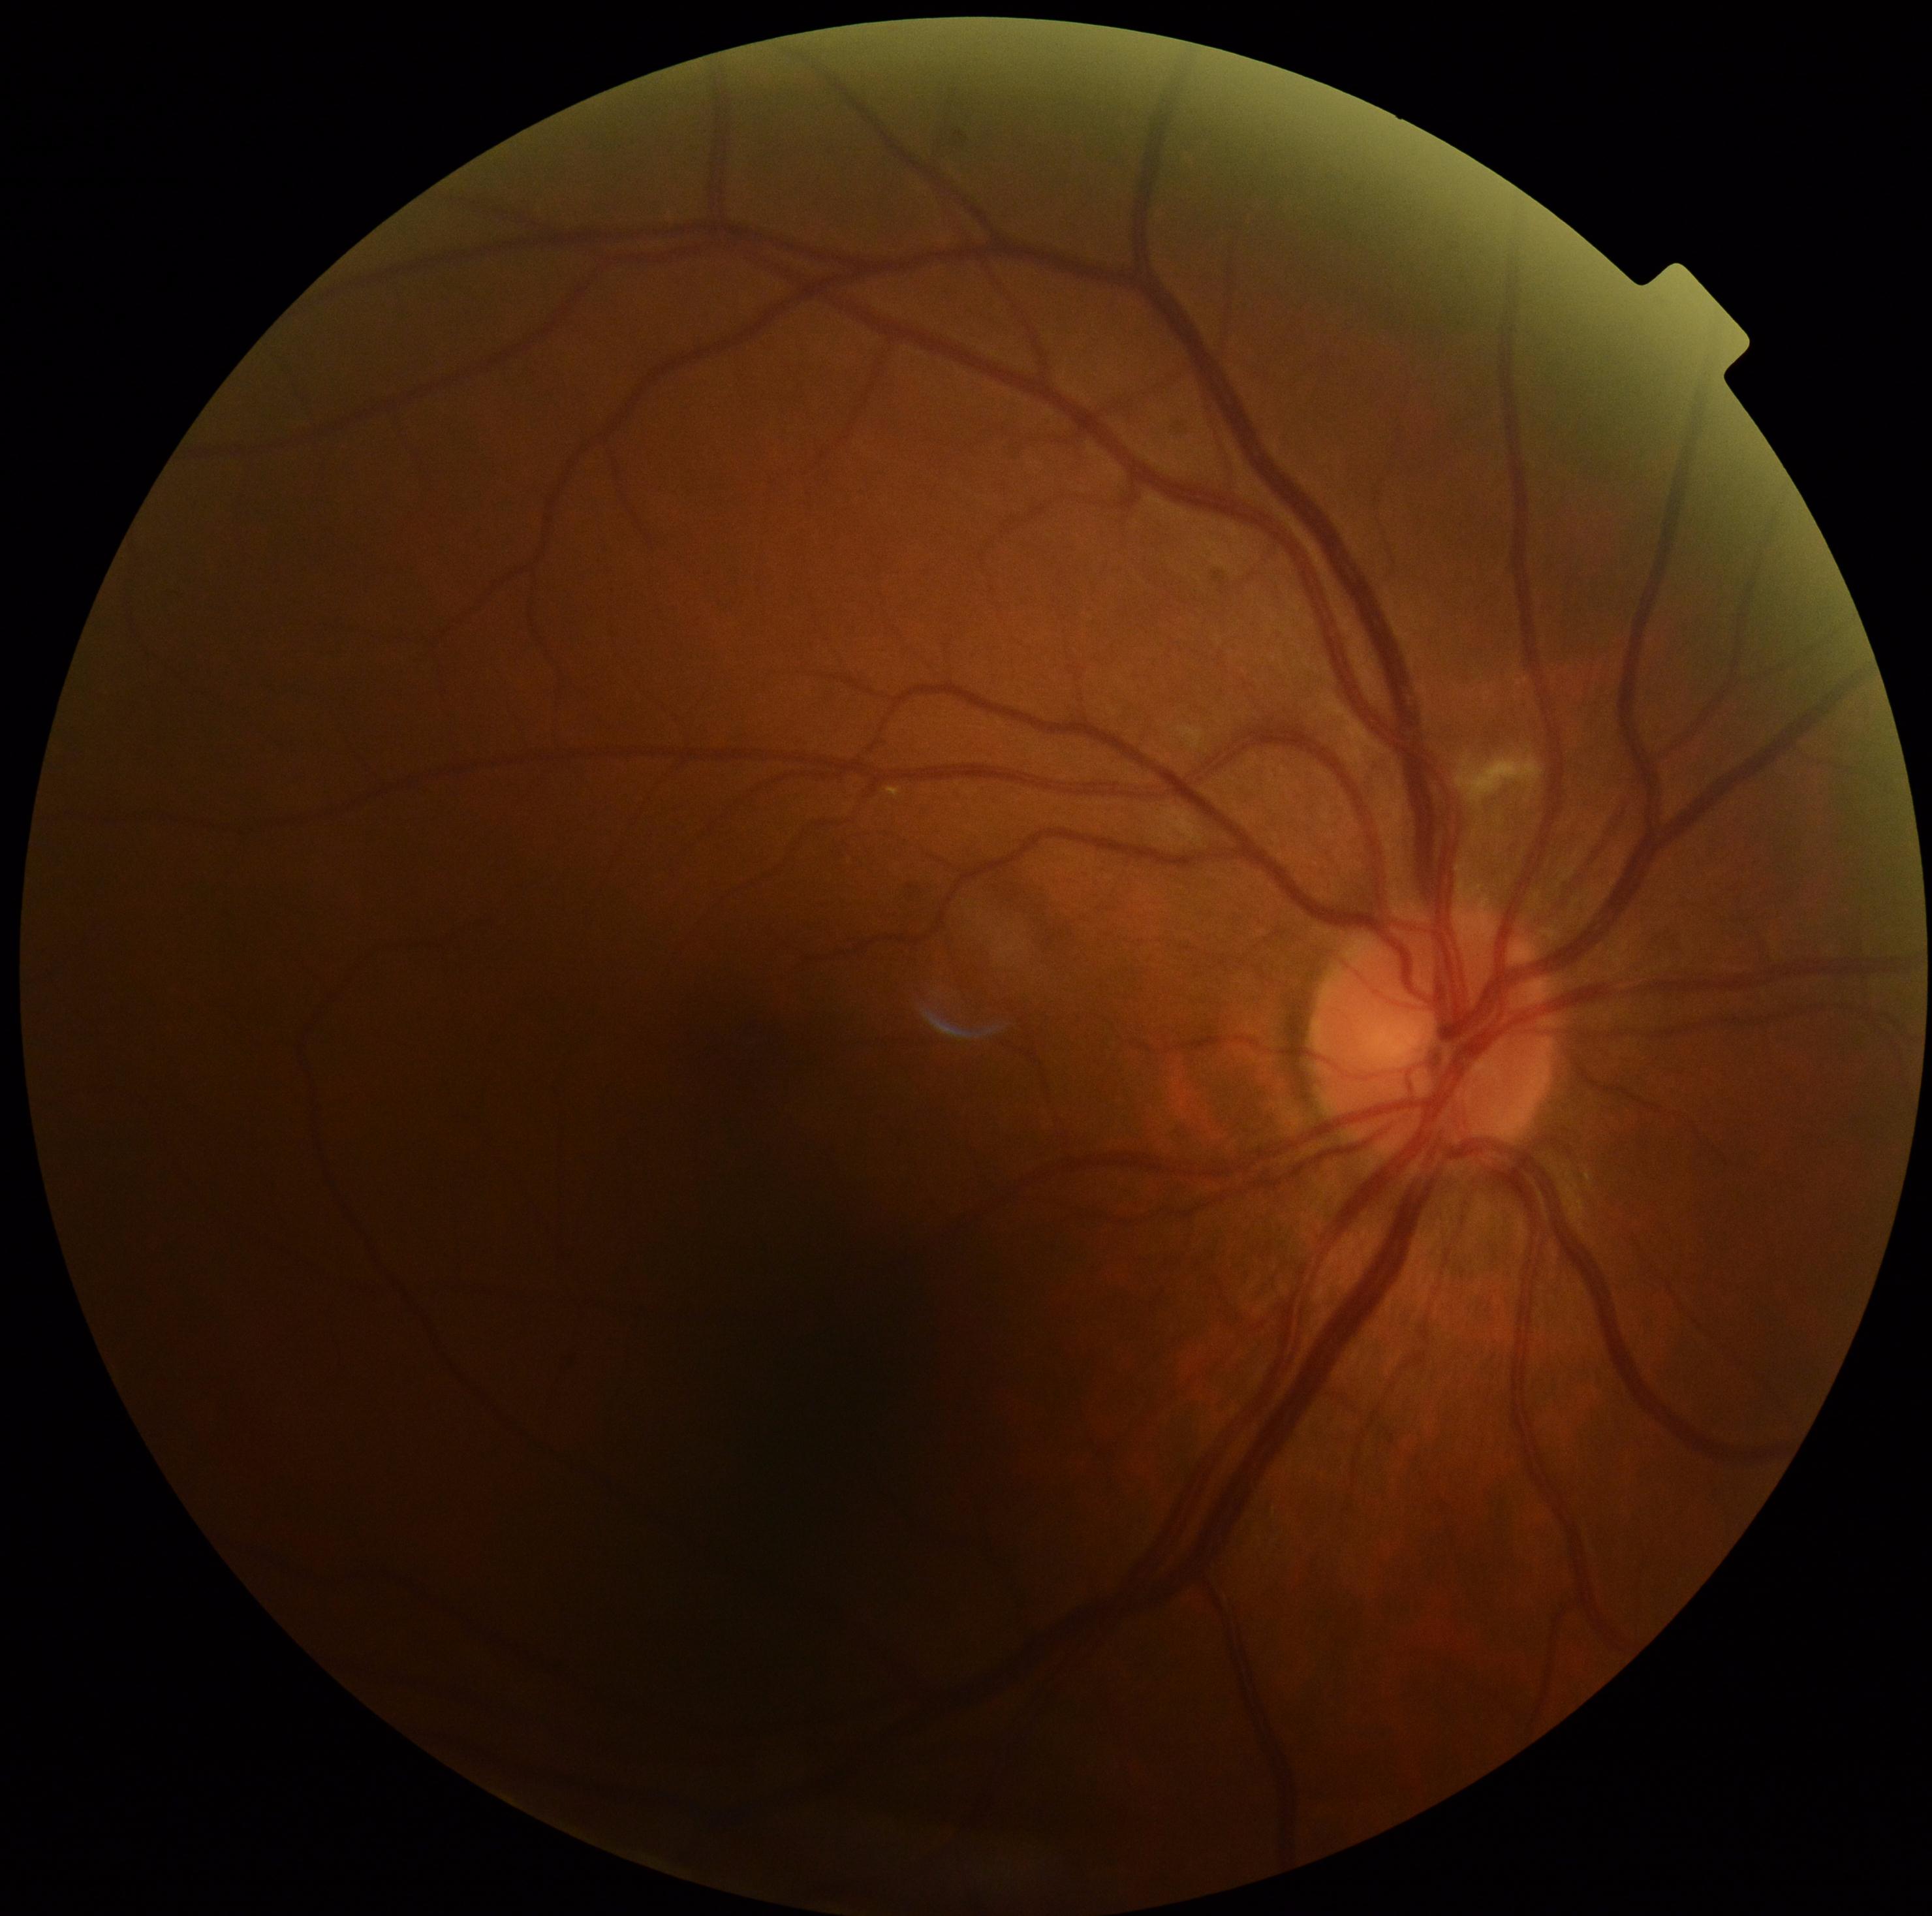
DR class = non-proliferative diabetic retinopathy; retinopathy = 2.